Diabetic retinopathy graded by the modified Davis classification: 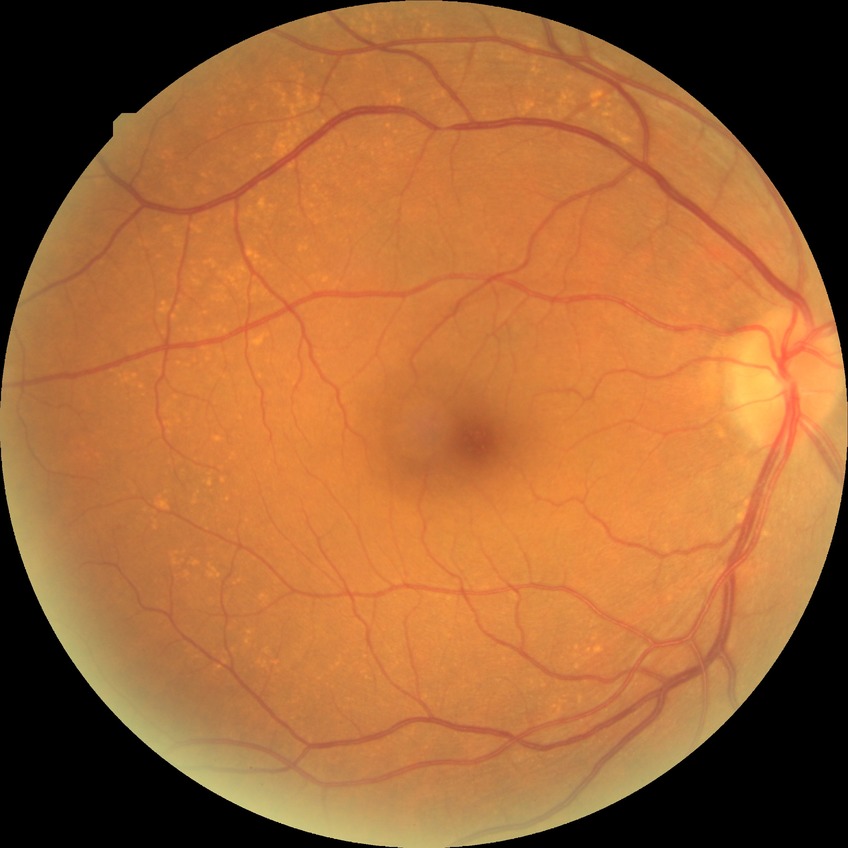
Findings:
- DR severity: NDR